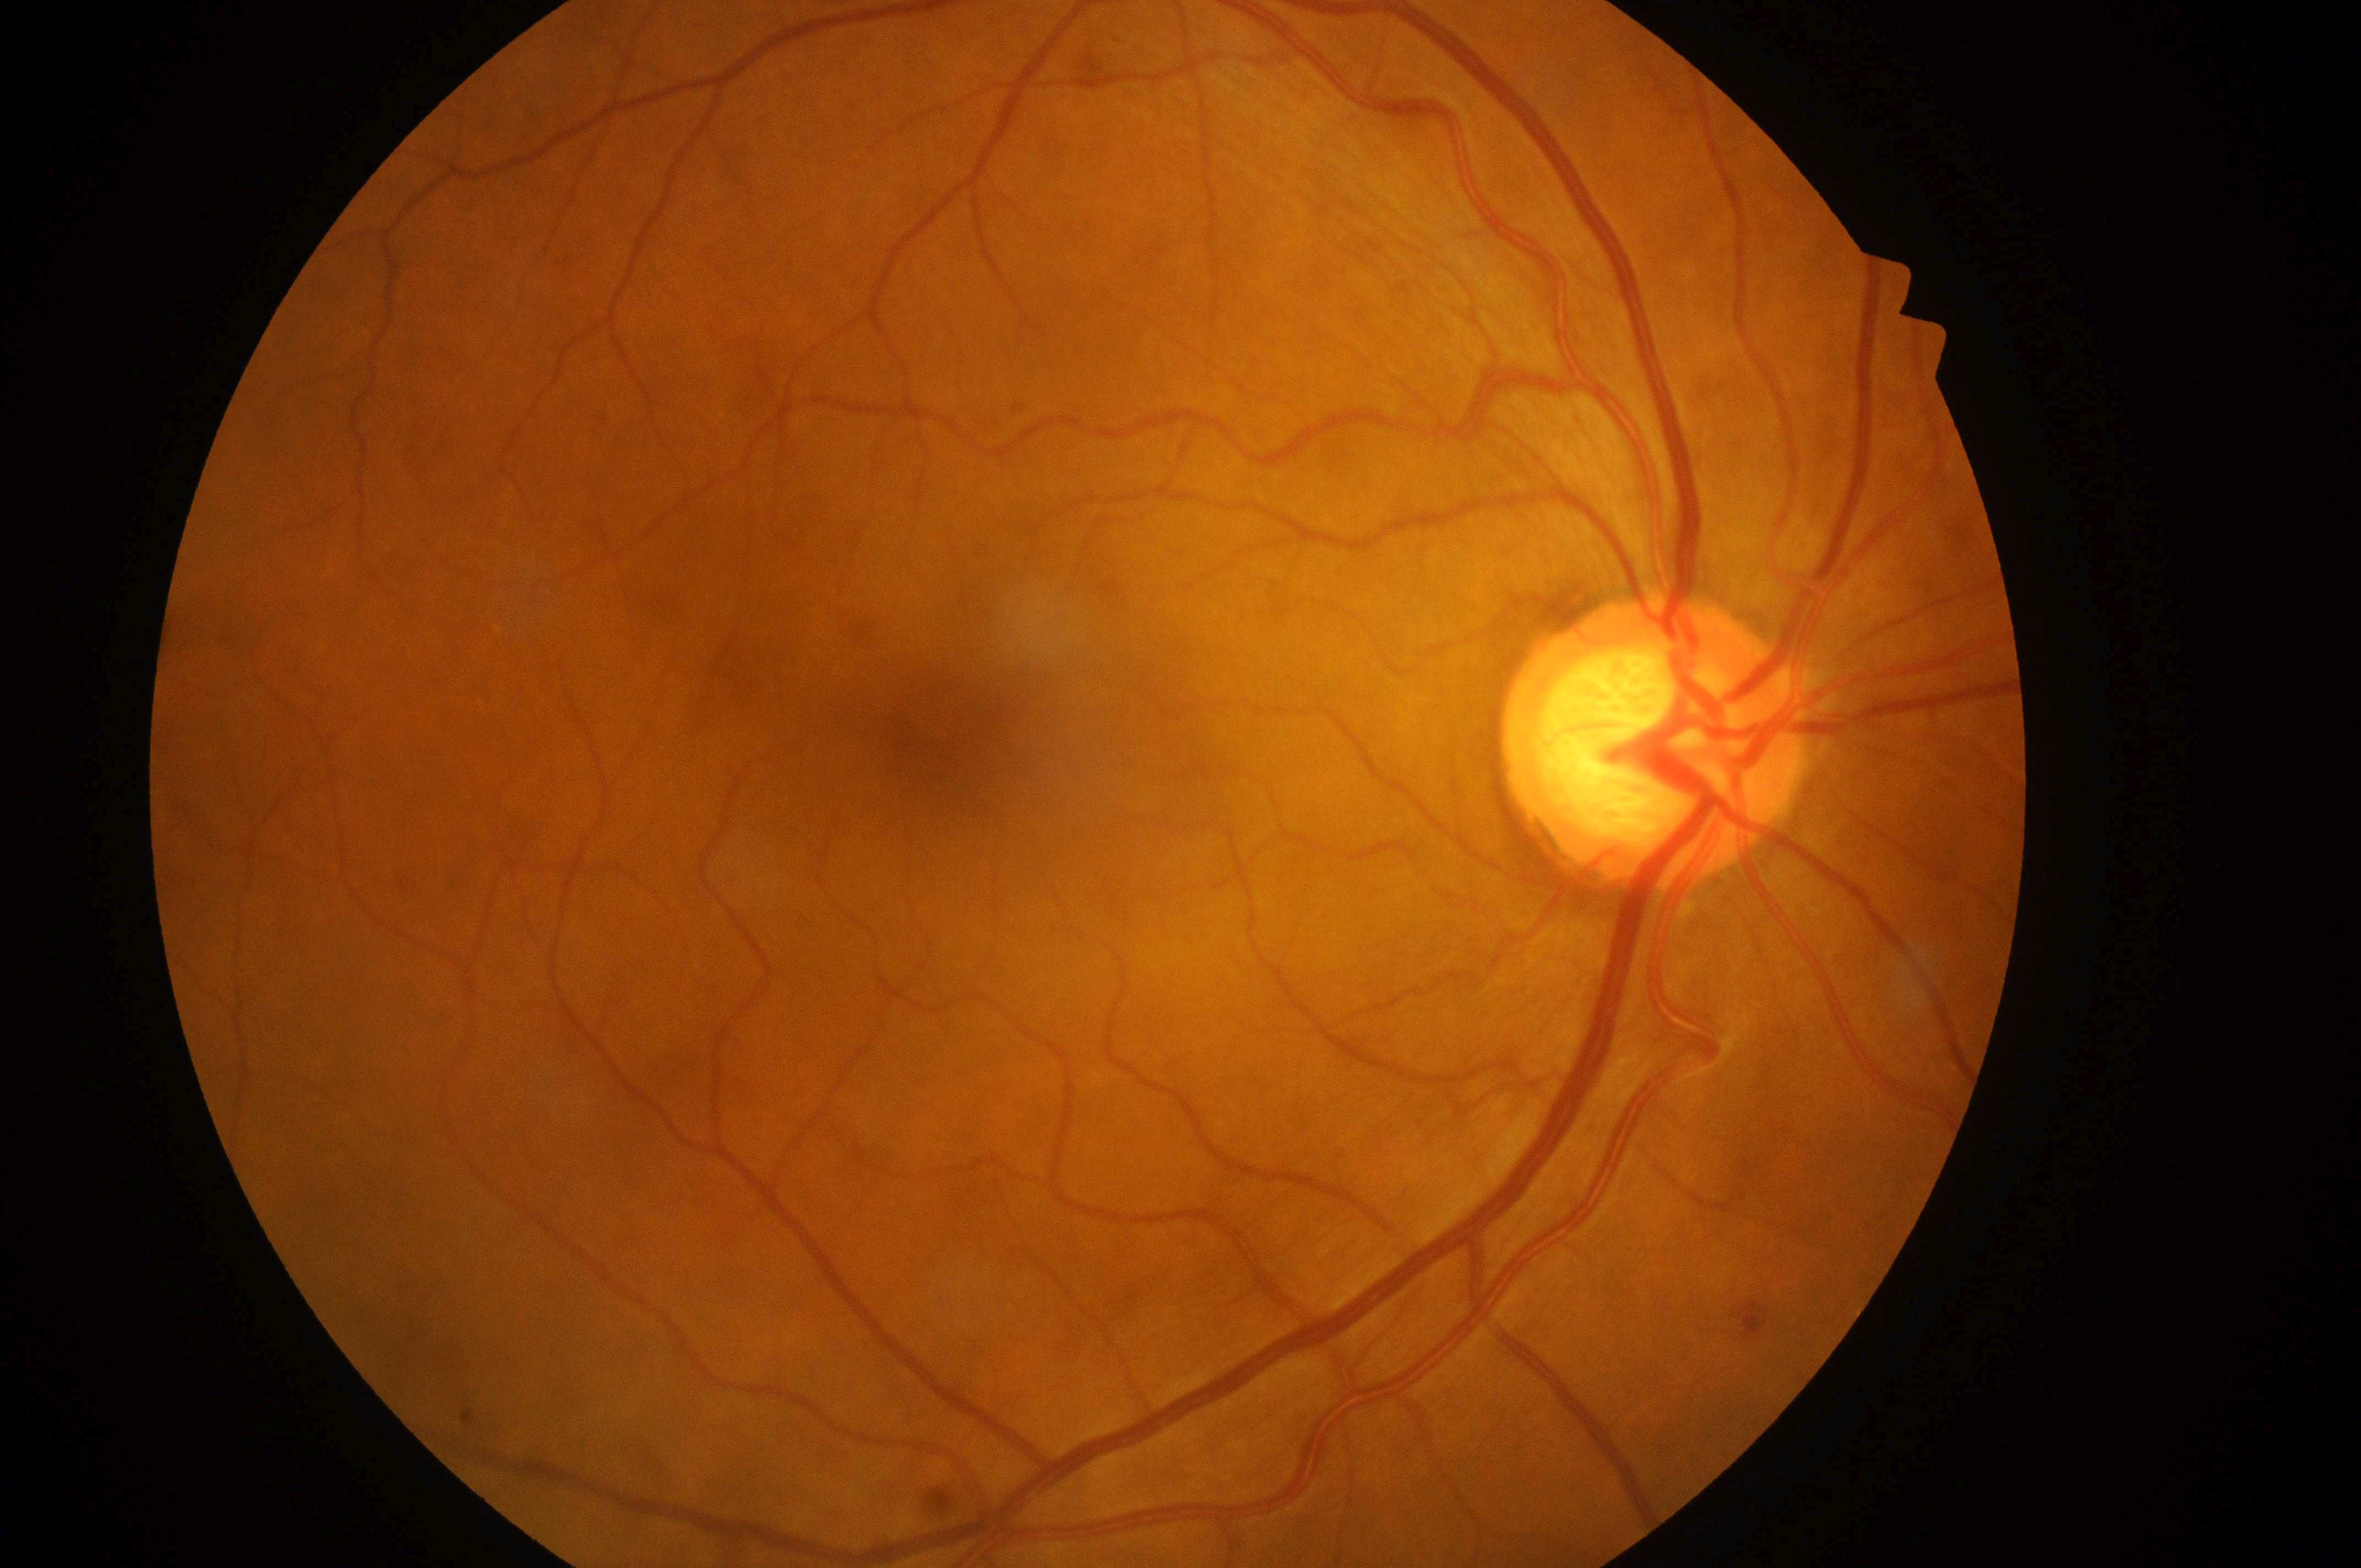

Diabetic retinopathy (DR) is mild non-proliferative diabetic retinopathy (grade 1).
Optic disk located at 1644px, 750px.
The fovea centralis is at 949px, 748px.
Imaged eye: right.
Diabetic macular edema (DME) is no risk (grade 0).